Image size 1924x1556; ultra-widefield fundus mosaic — 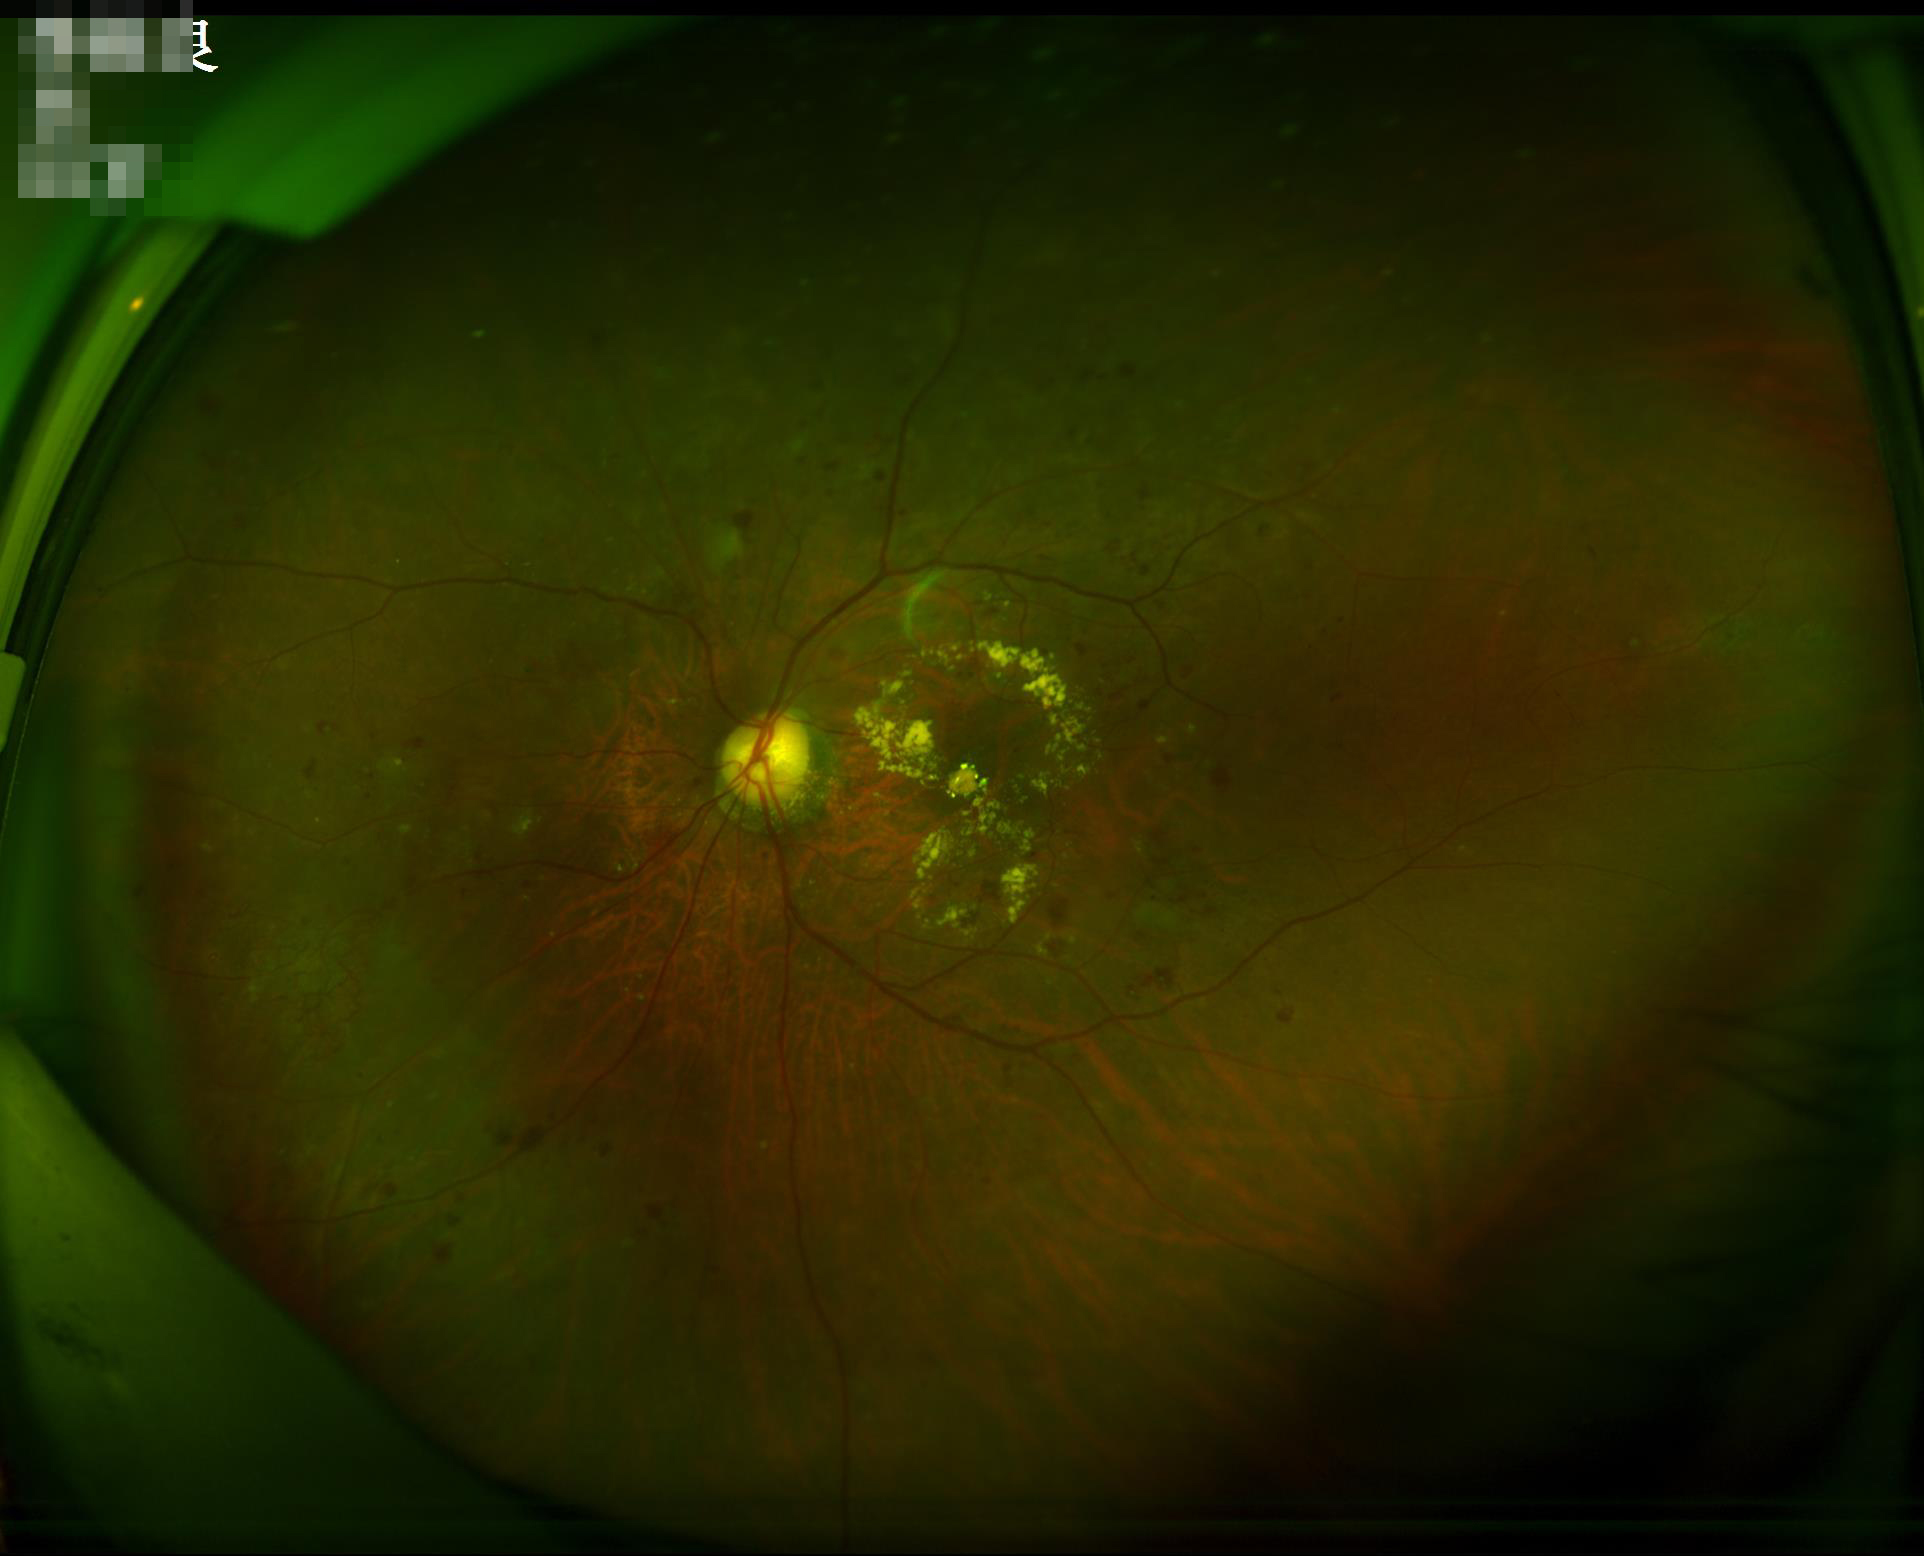 Image is sharp throughout the field.
Acceptable image quality.
Poor illumination with uneven exposure.